Color fundus image · camera: Remidio Fundus on Phone · 1659x2212px:
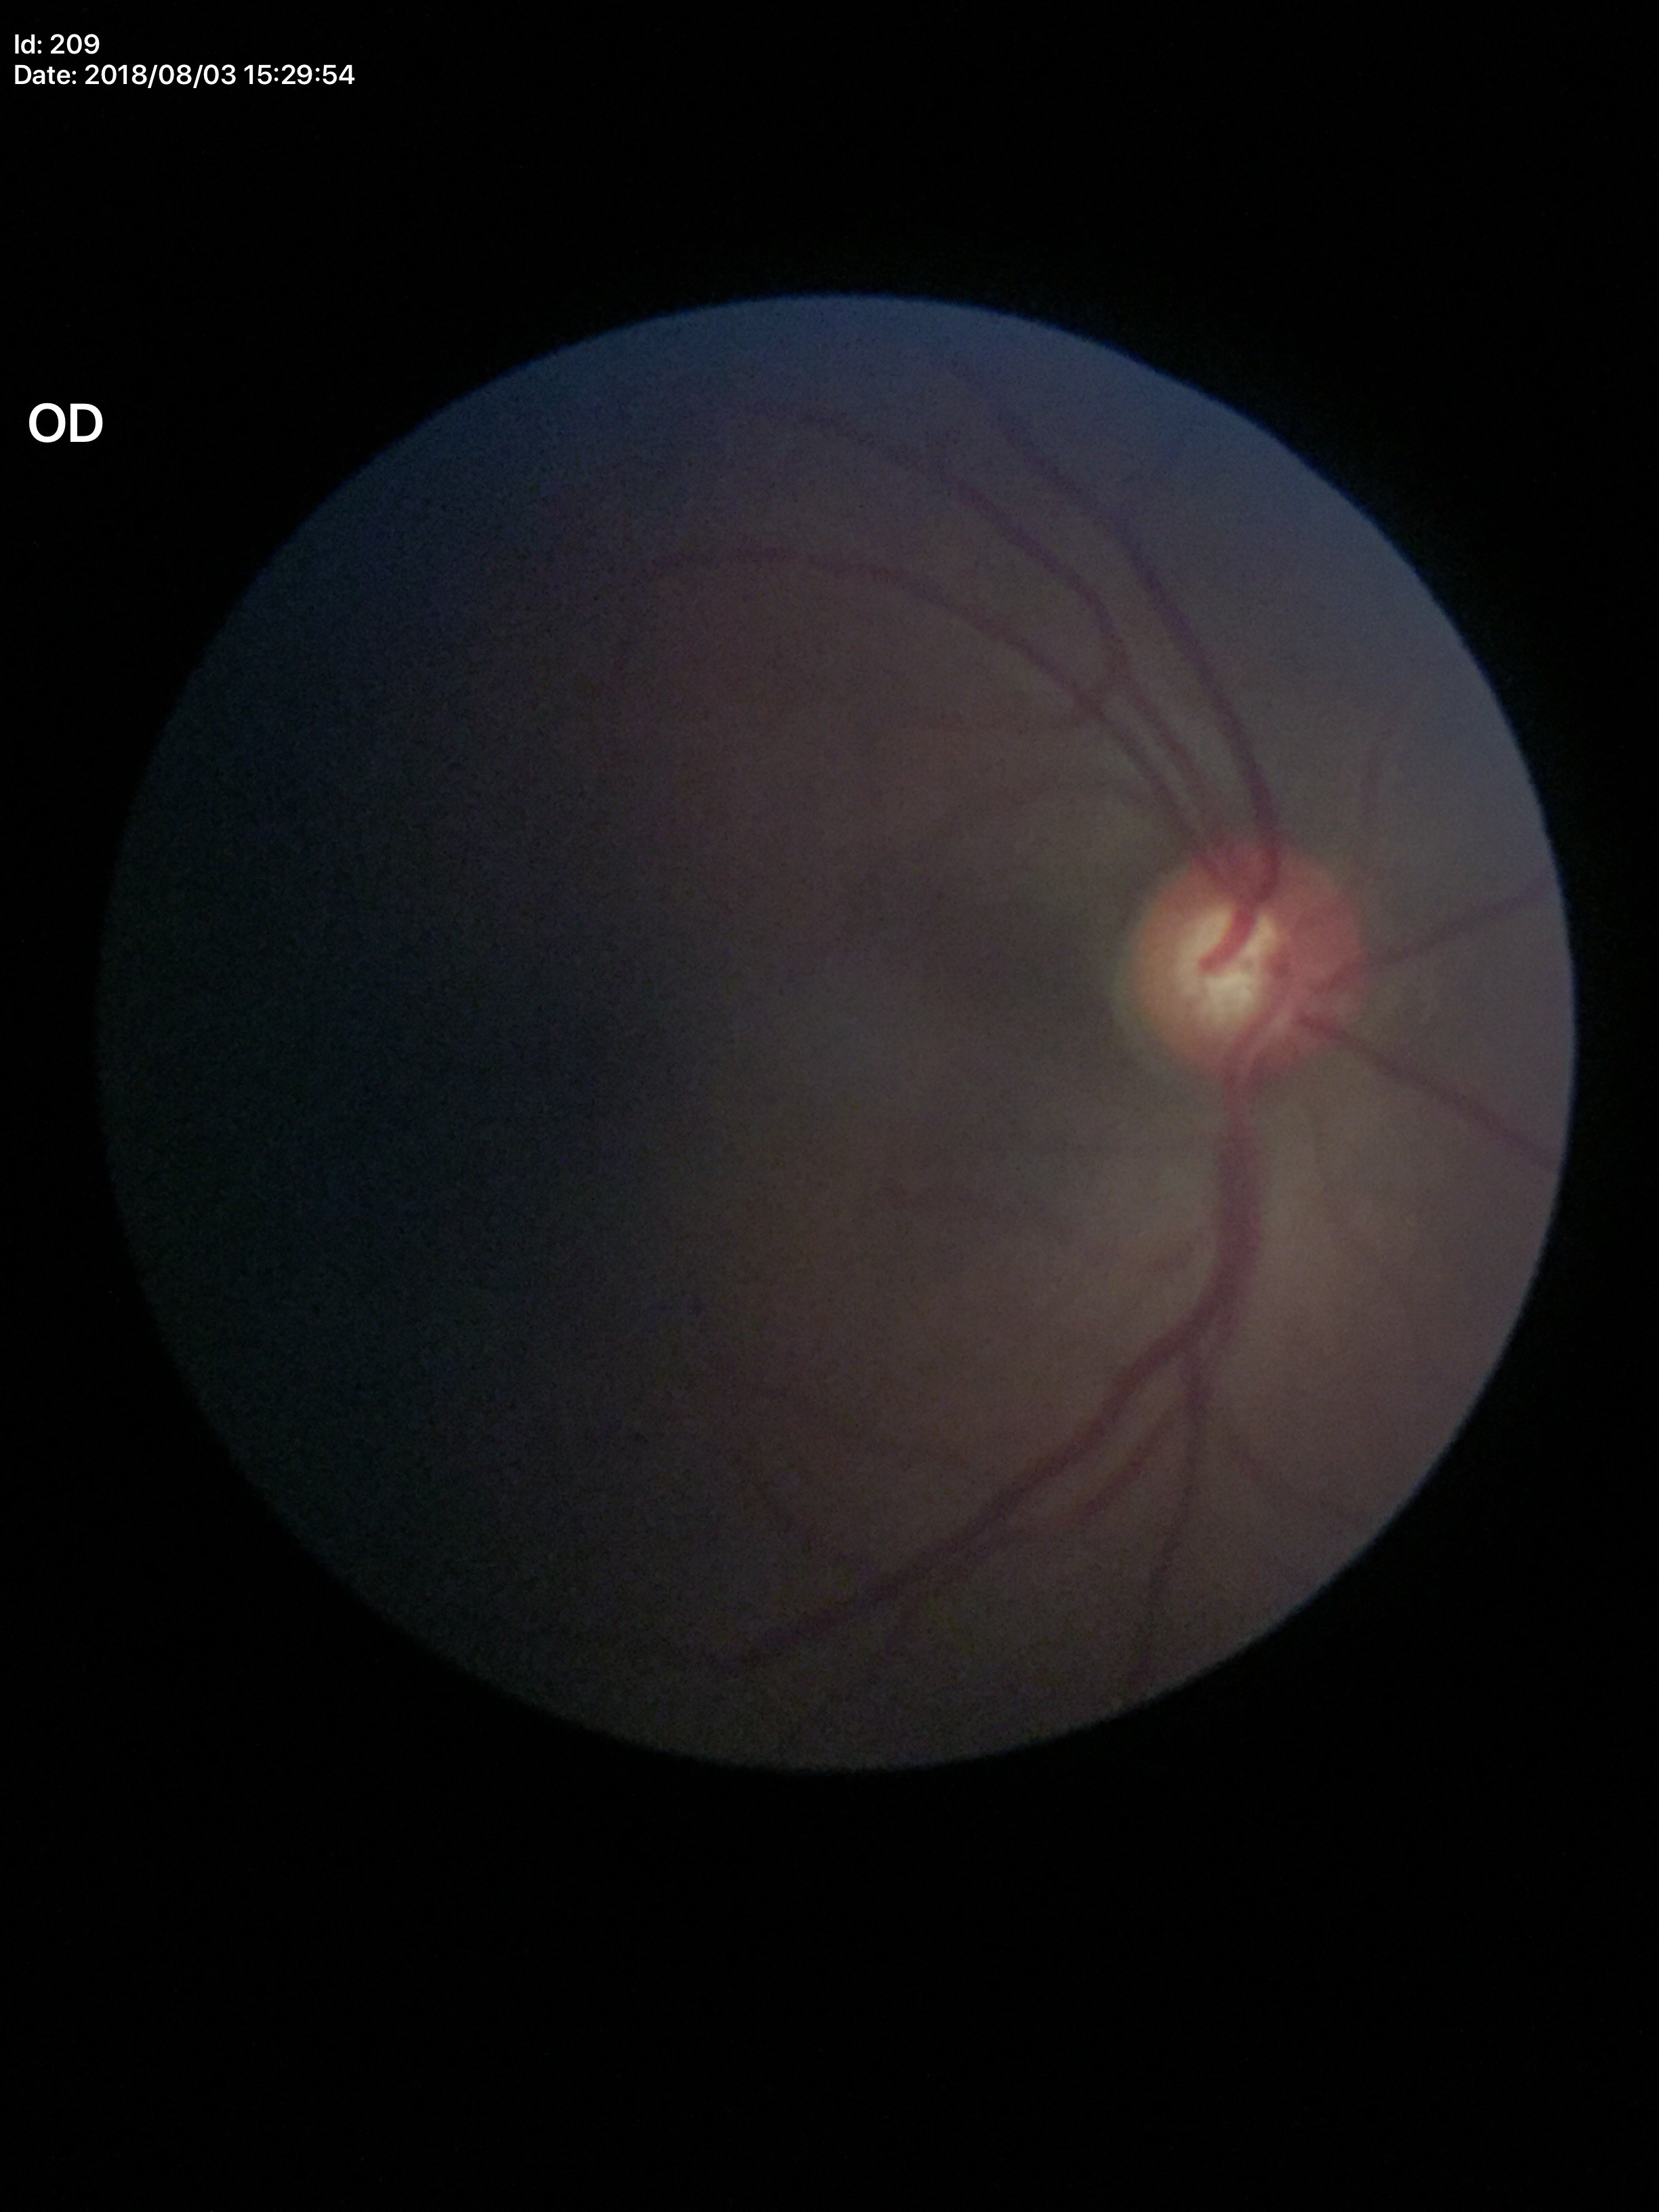

{
  "glaucoma_decision": "no suspicious findings",
  "vcdr": "0.58",
  "hcdr": "0.51"
}